45° FOV
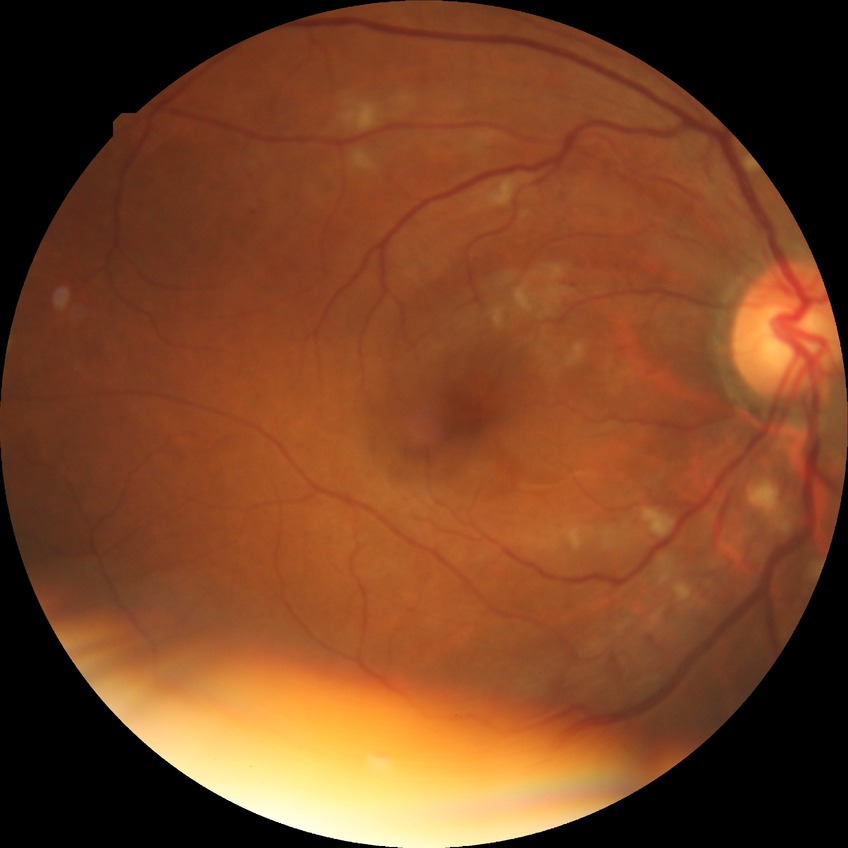
retinopathy grade: pre-proliferative diabetic retinopathy.